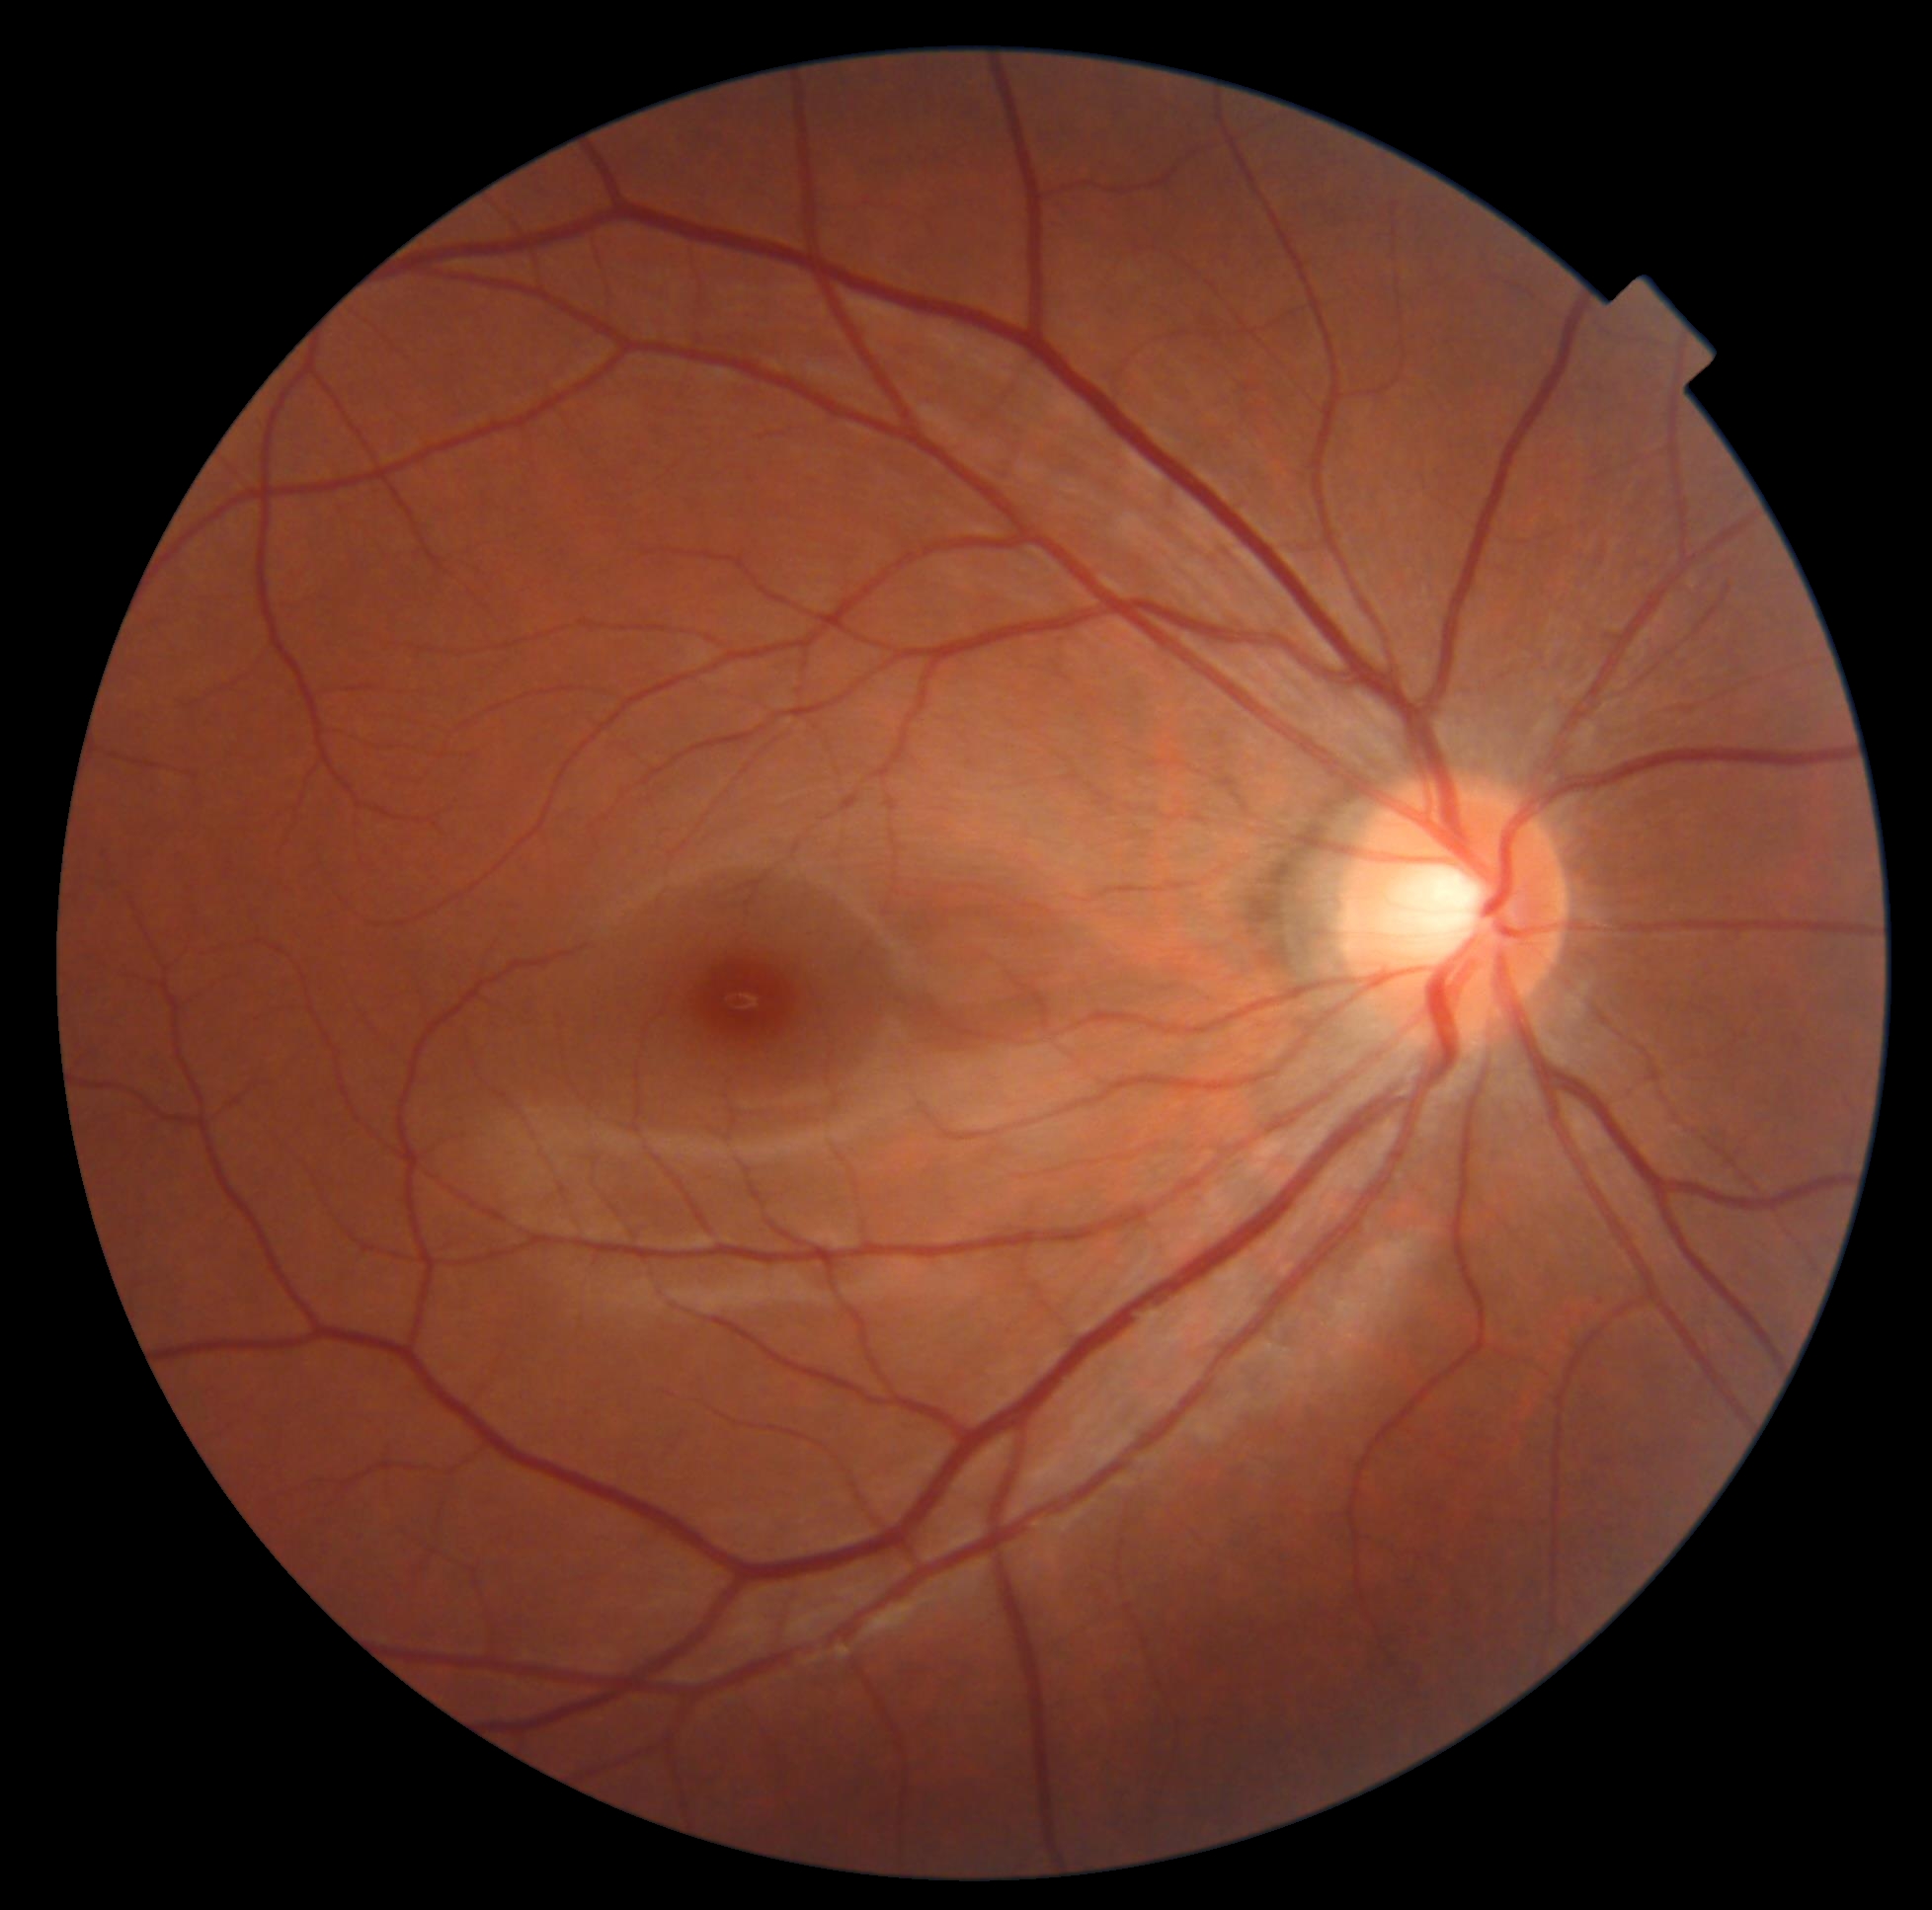

Diabetic retinopathy grade: 0 (no apparent retinopathy).